Pediatric wide-field fundus photograph.
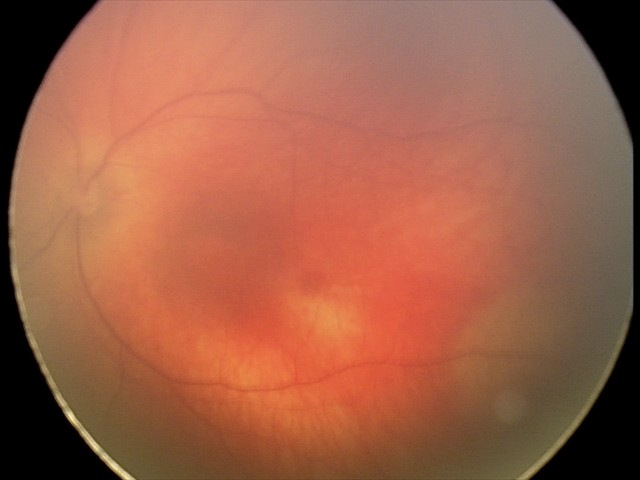 Screening examination diagnosed as physiological.